NIDEK AFC-230 fundus camera · 45° field of view · fundus photo — 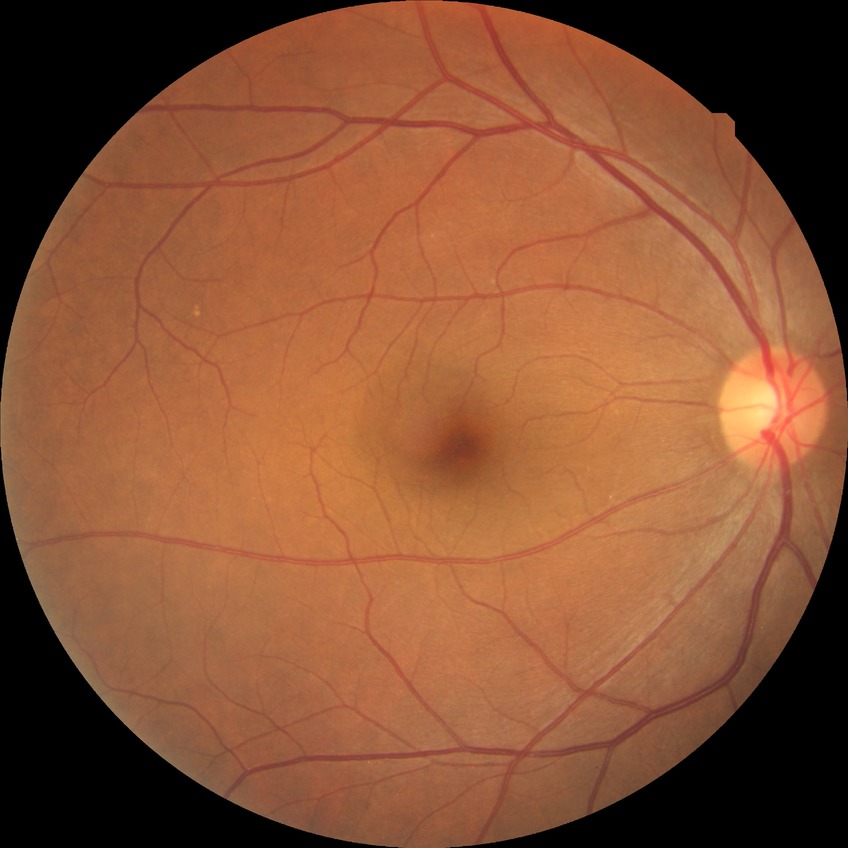
DR impression: no apparent DR
DR grade: NDR